Pediatric wide-field fundus photograph. Acquired on the Phoenix ICON:
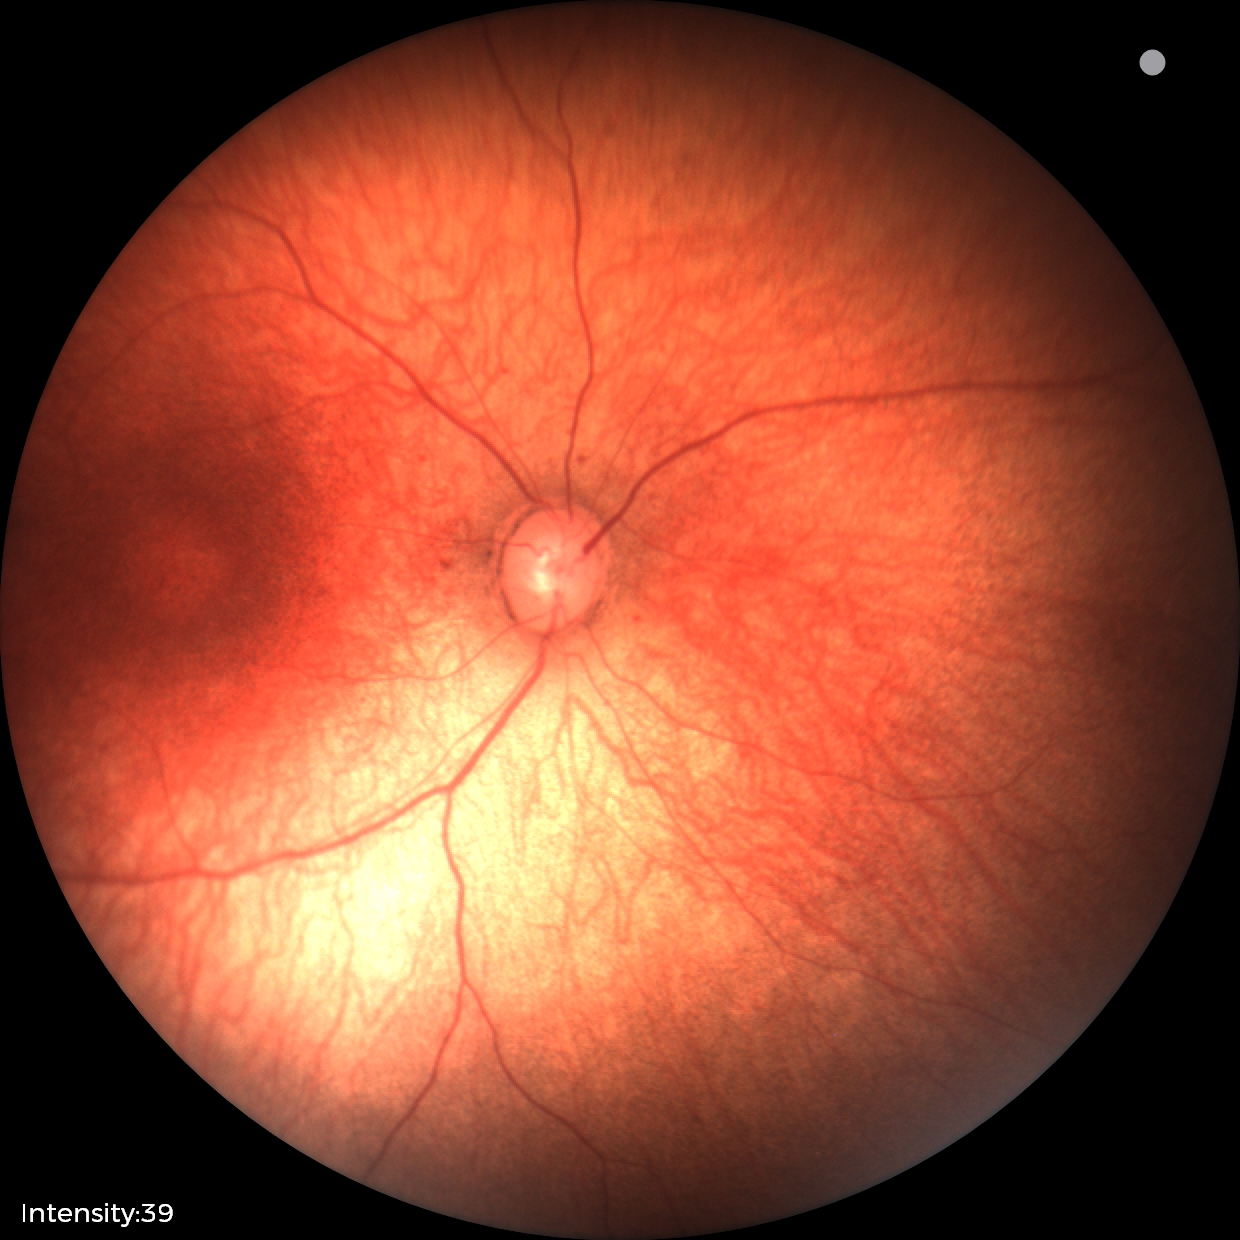
Screening diagnosis: no abnormalities